CFP — 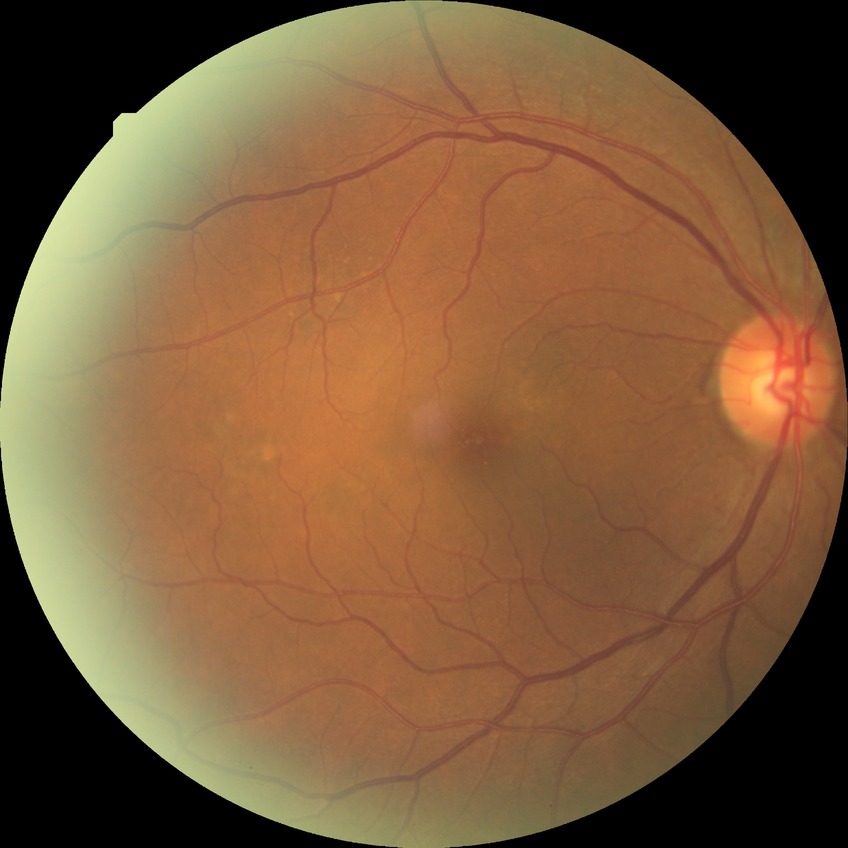 diabetic retinopathy (DR): no diabetic retinopathy (NDR).